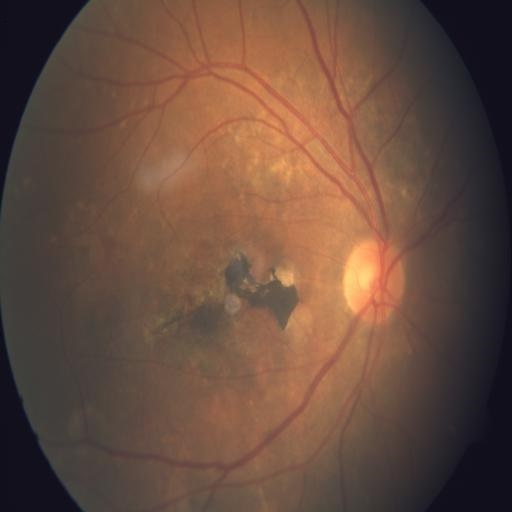
This fundus photograph shows chorioretinitis.